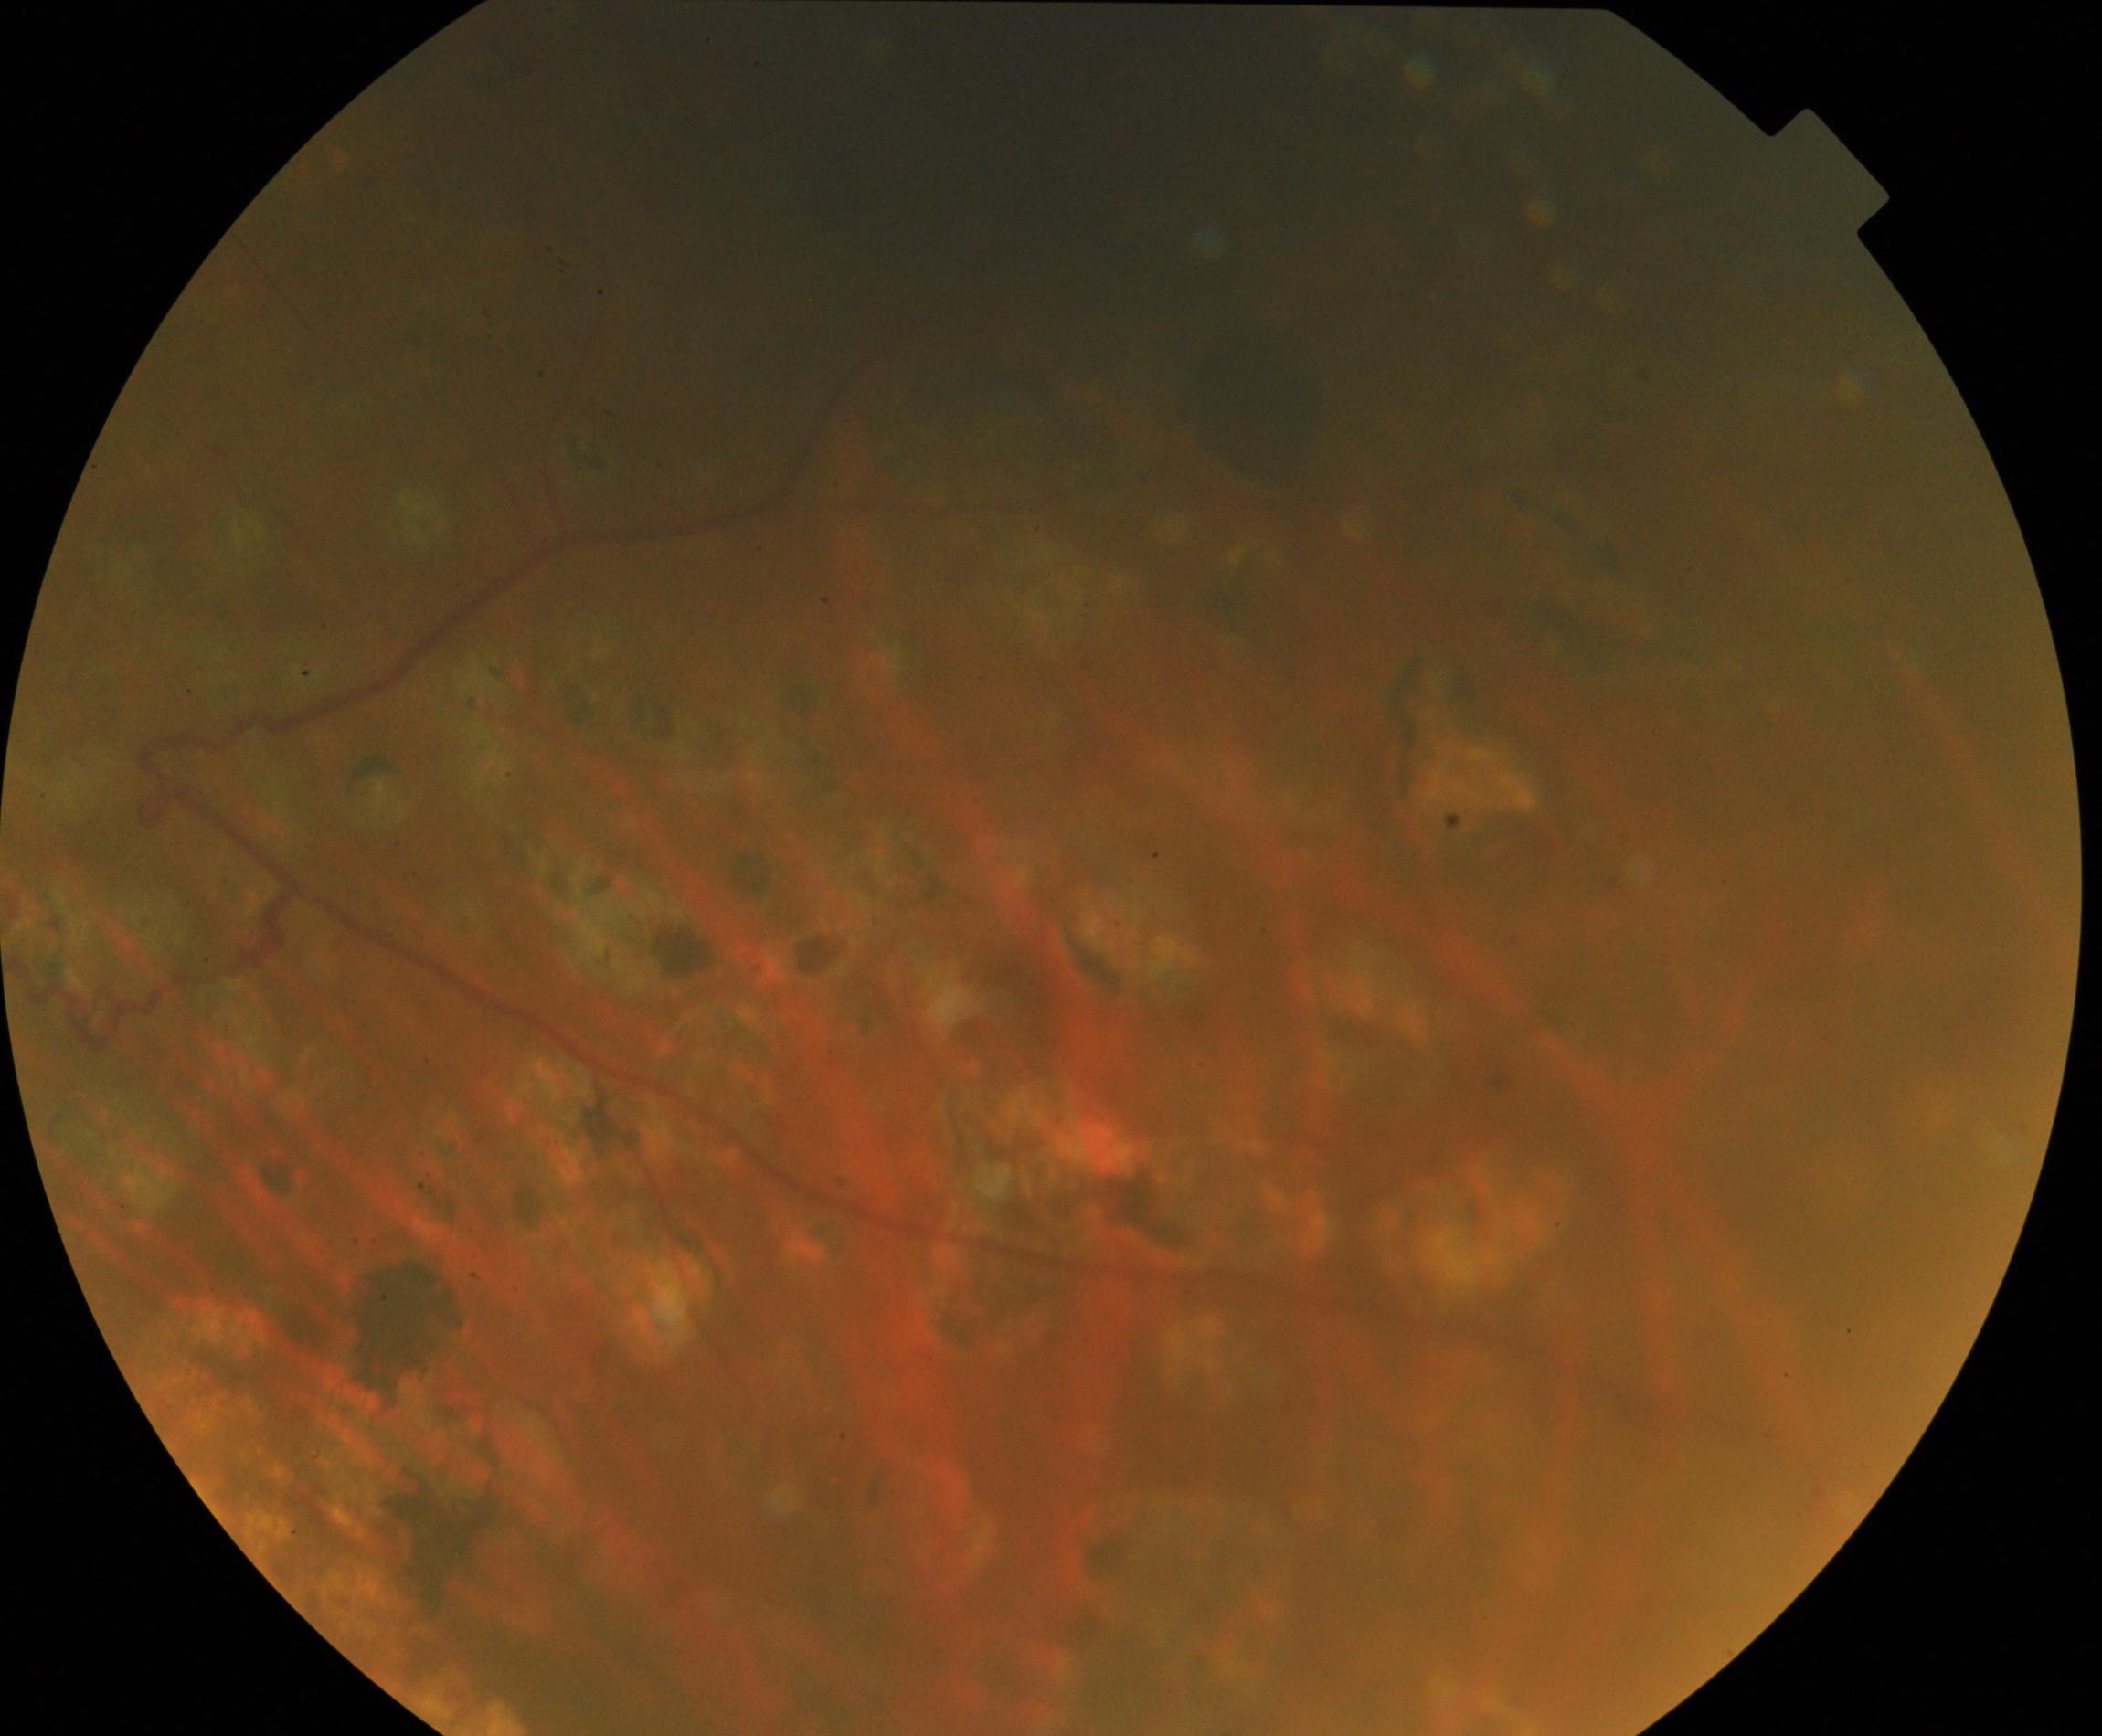

This fundus photograph shows laser spots.